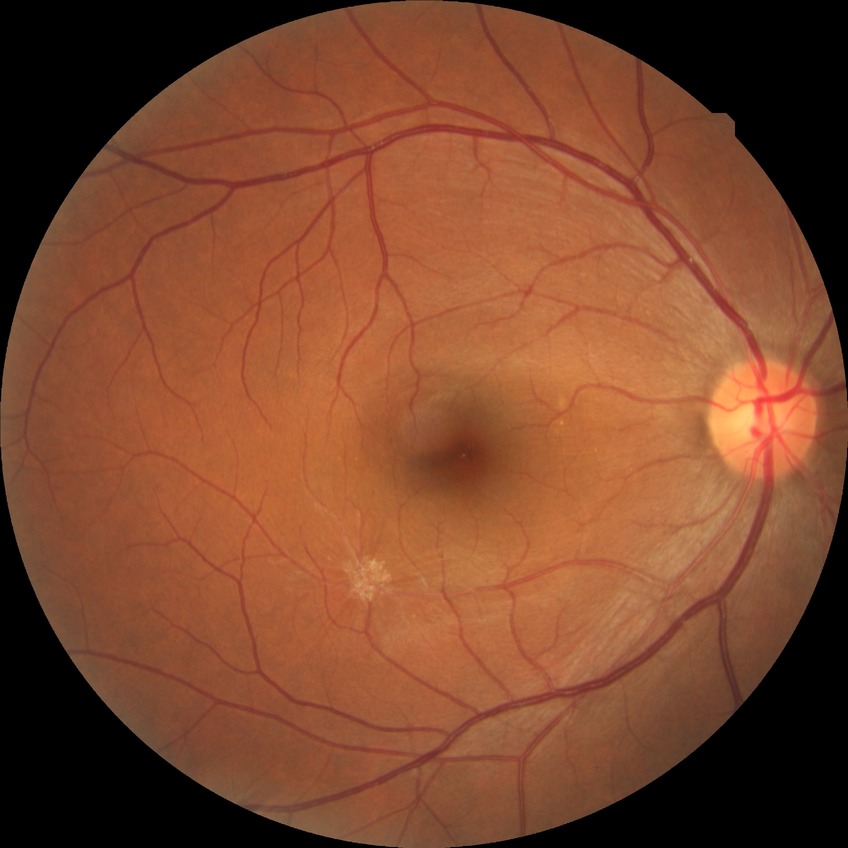

Diabetic retinopathy (DR): NDR (no diabetic retinopathy).